Retinal fundus photograph · 1536x1152px: 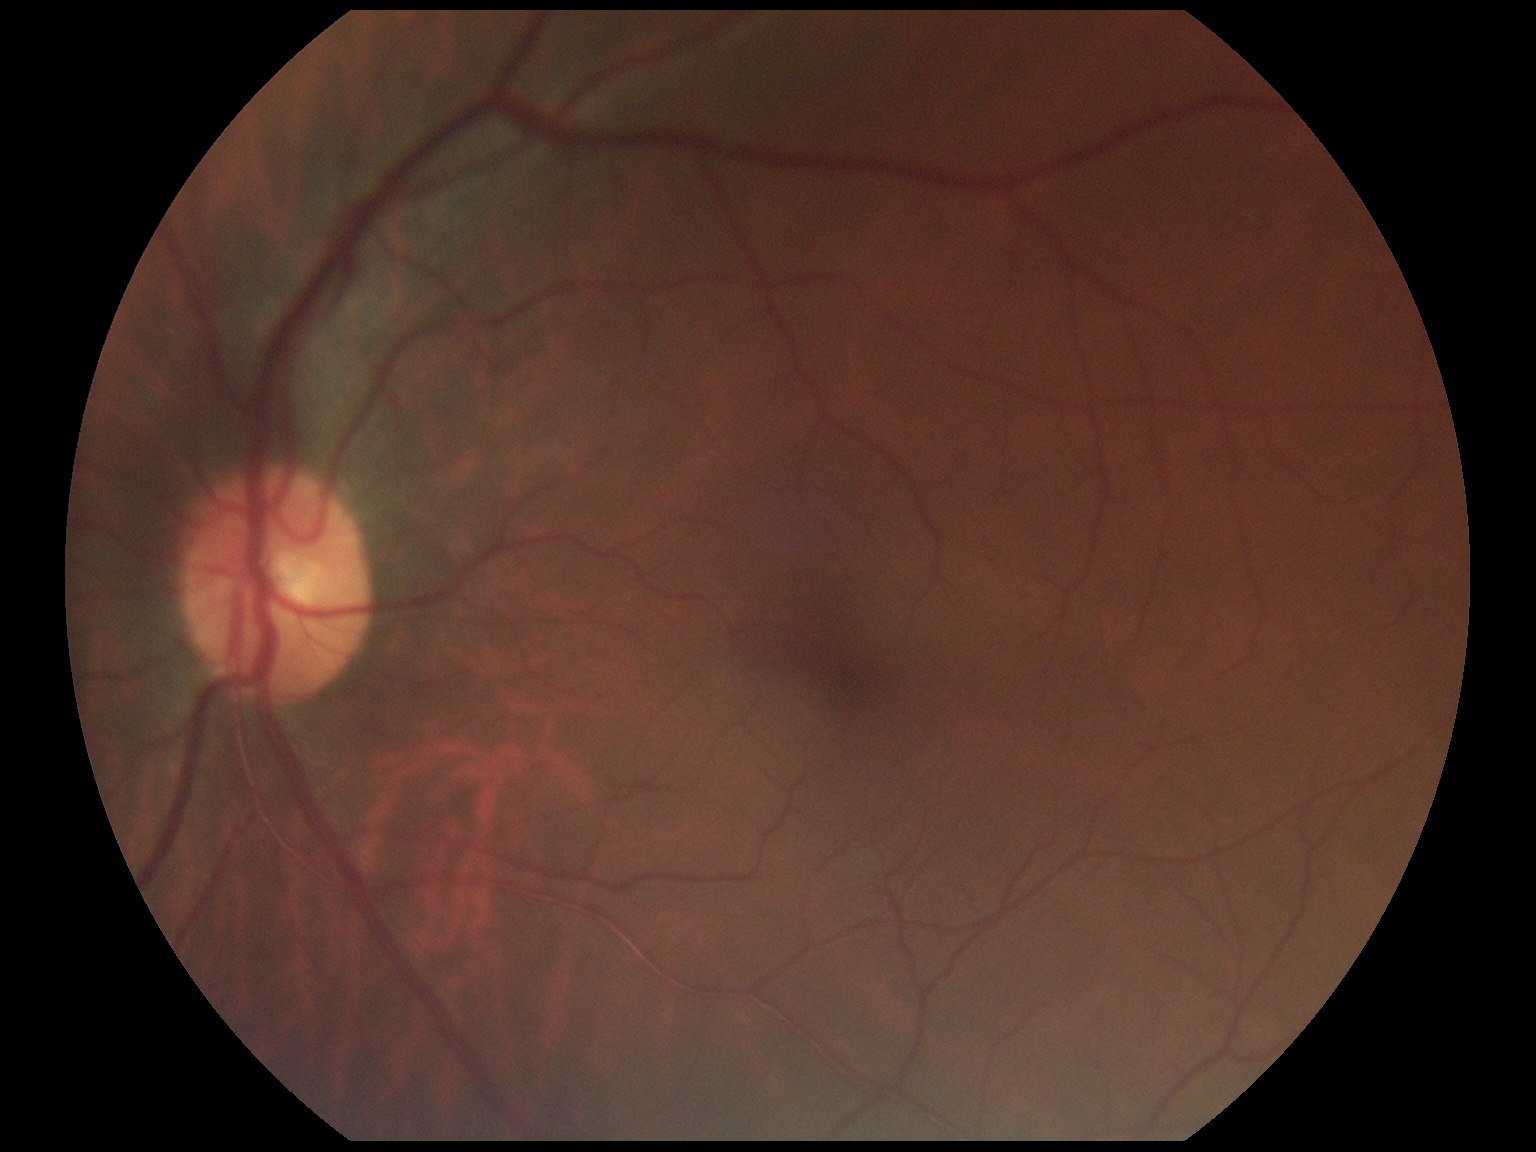
DR severity: 0/4. No signs of diabetic retinopathy.